Wide-field fundus photograph of an infant. Camera: Clarity RetCam 3 (130° FOV).
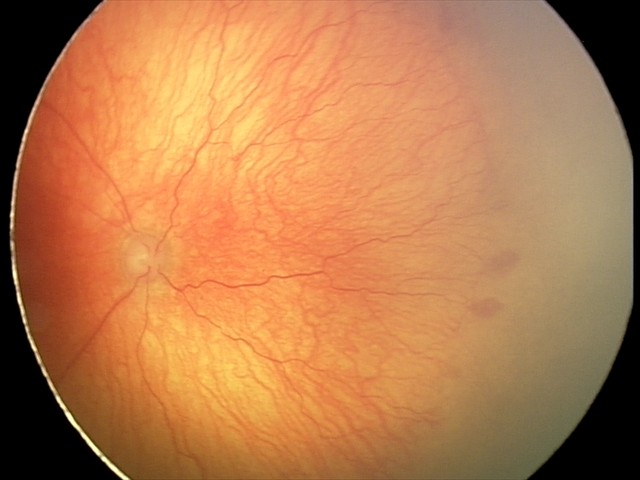

Examination diagnosed as aggressive ROP (A-ROP) — rapidly progressive severe ROP with prominent plus disease, often without classic stage progression. Plus disease was diagnosed.